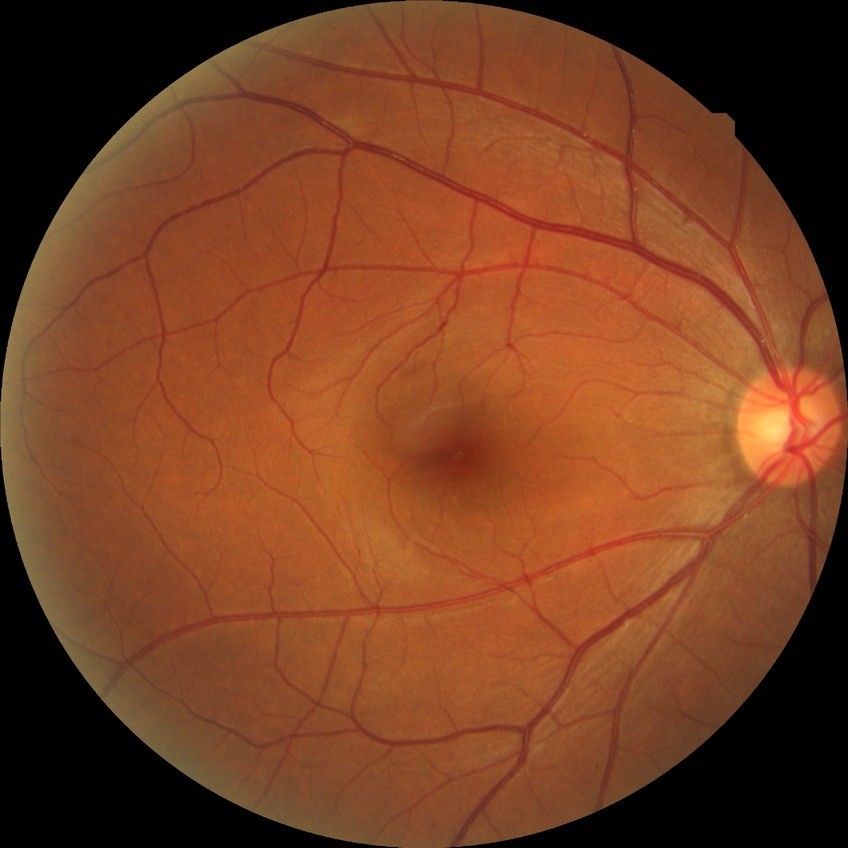
Modified Davis classification: no diabetic retinopathy.